Color fundus photograph
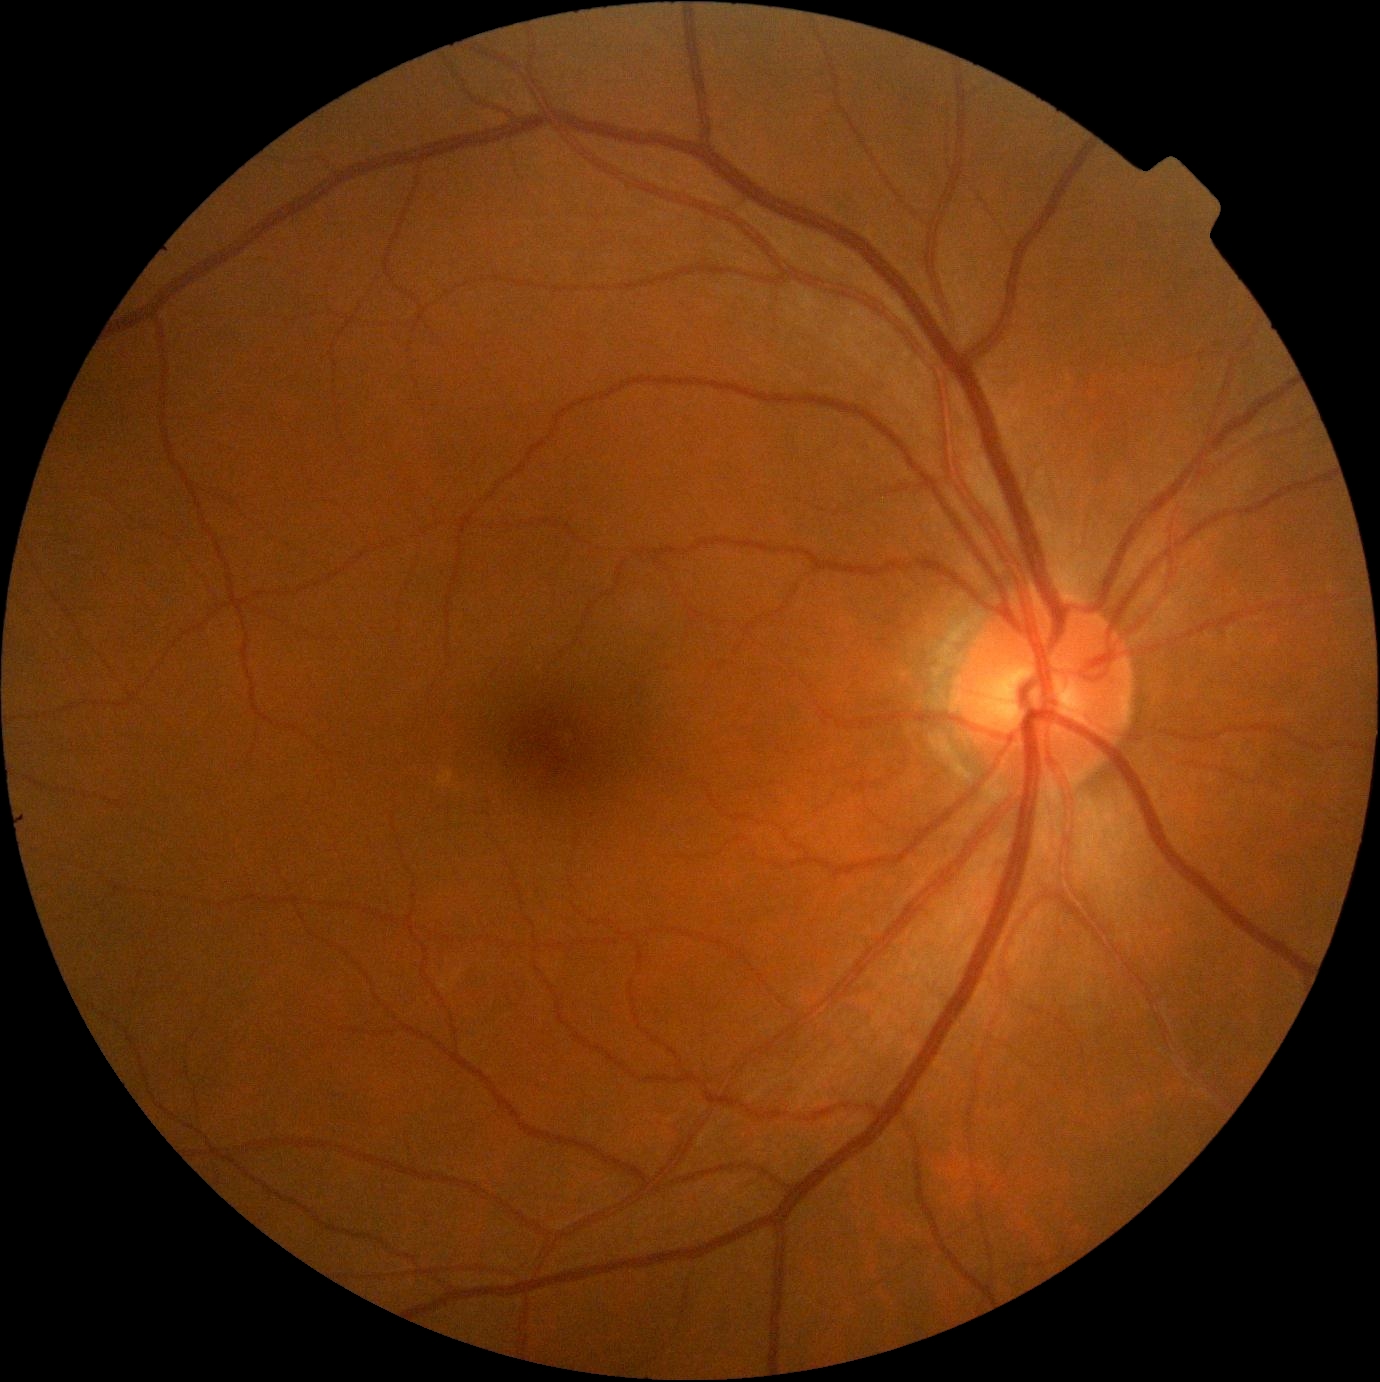
Findings:
- DR impression: no signs of DR
- DR: grade 0